Color fundus image.
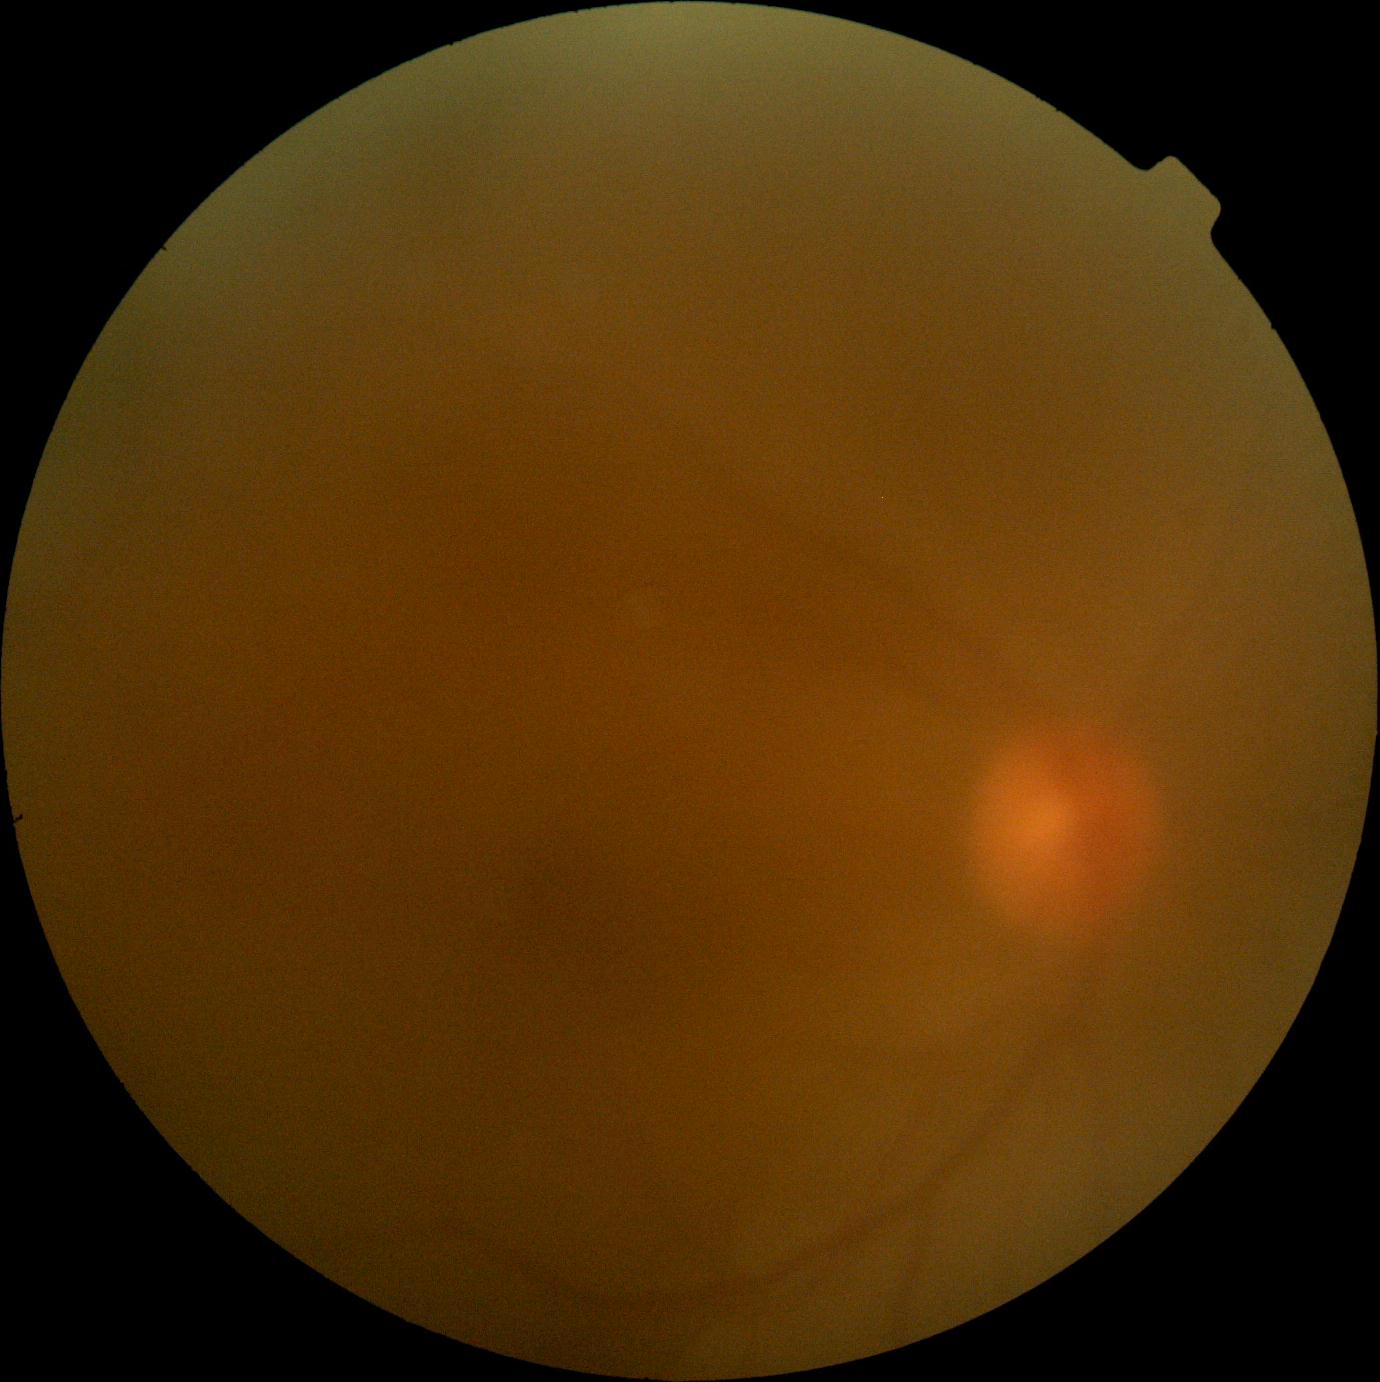 diabetic retinopathy=ungradable.